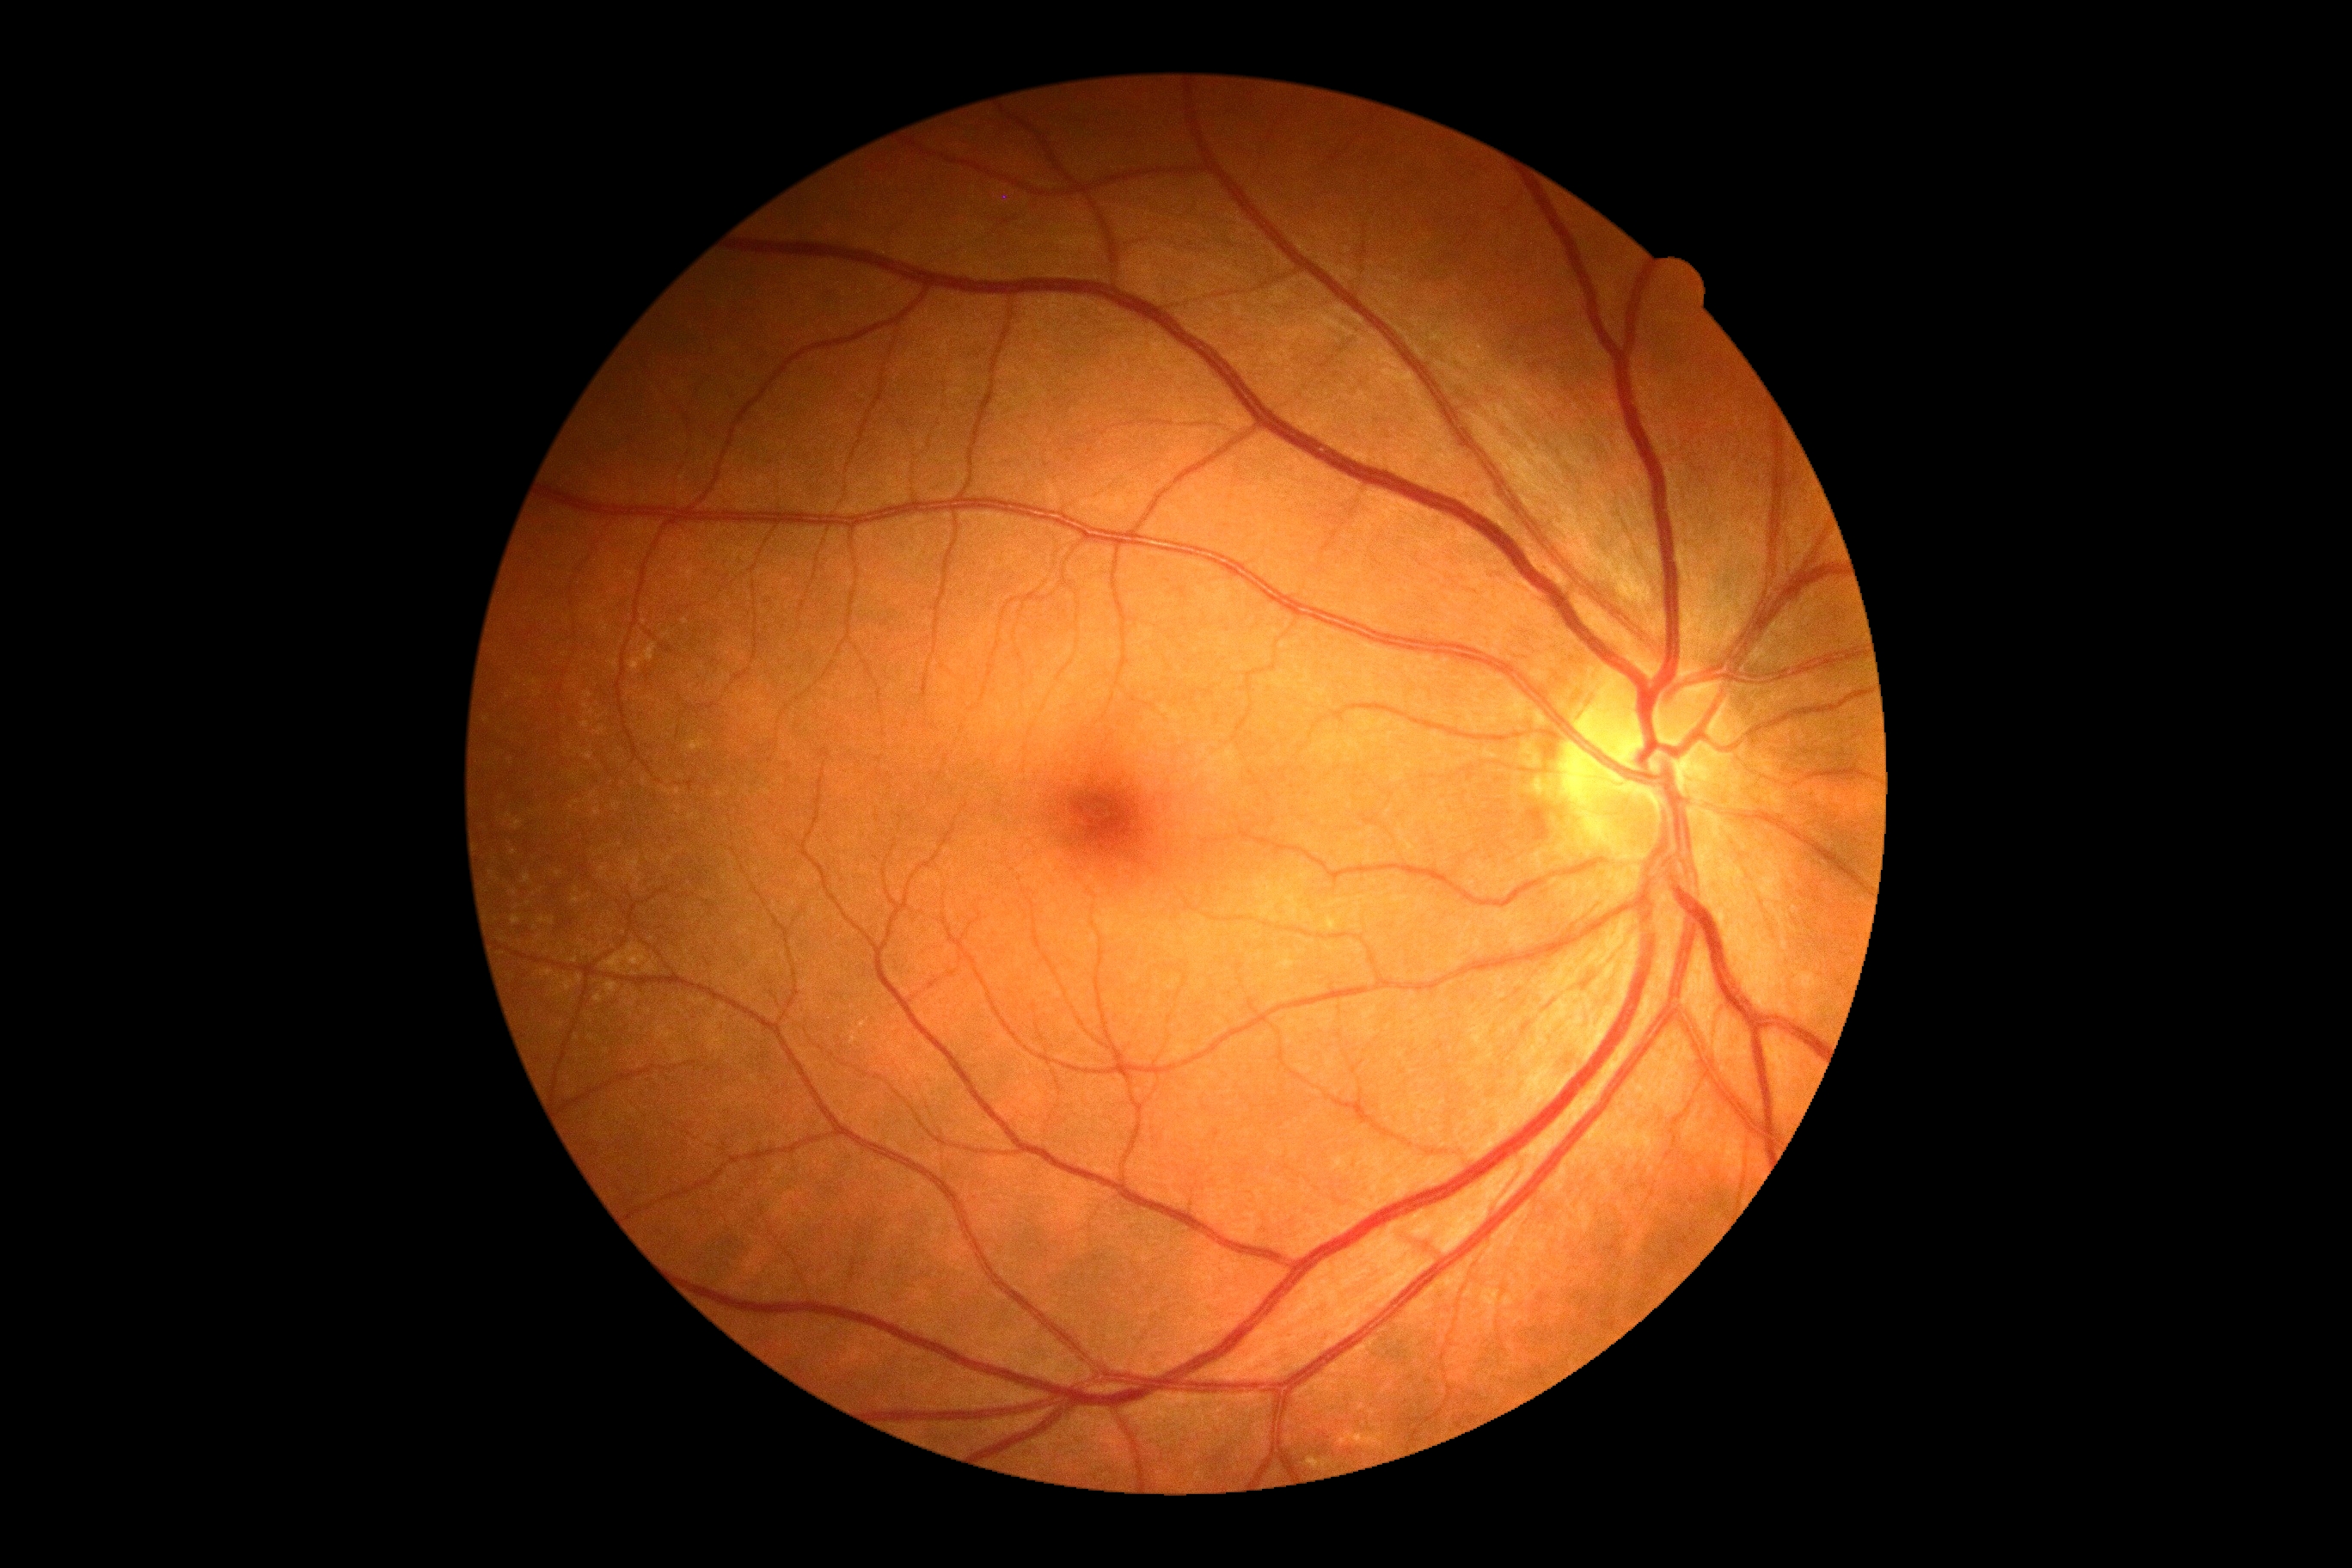 DR: grade 0 (no apparent retinopathy).